1240 by 1240 pixels. Infant wide-field fundus photograph: 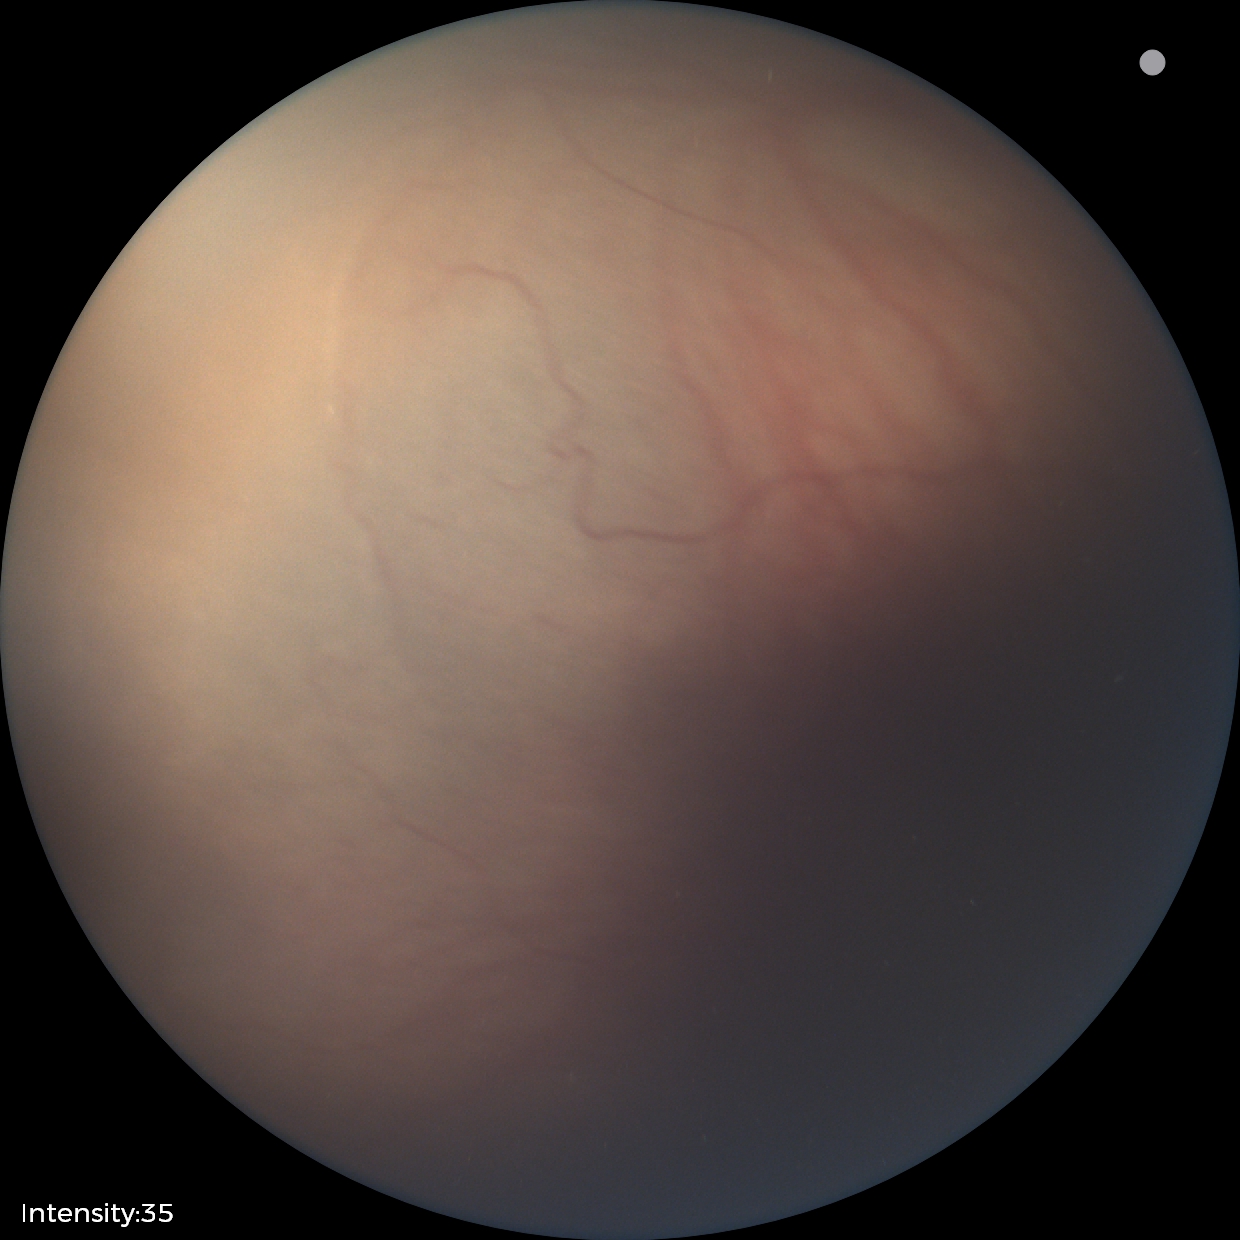
No plus disease. From an examination with diagnosis of retinopathy of prematurity (ROP) stage 1 — demarcation line between vascular and avascular retina.